Captured with the Phoenix ICON (100° field of view) · wide-field fundus photograph from neonatal ROP screening
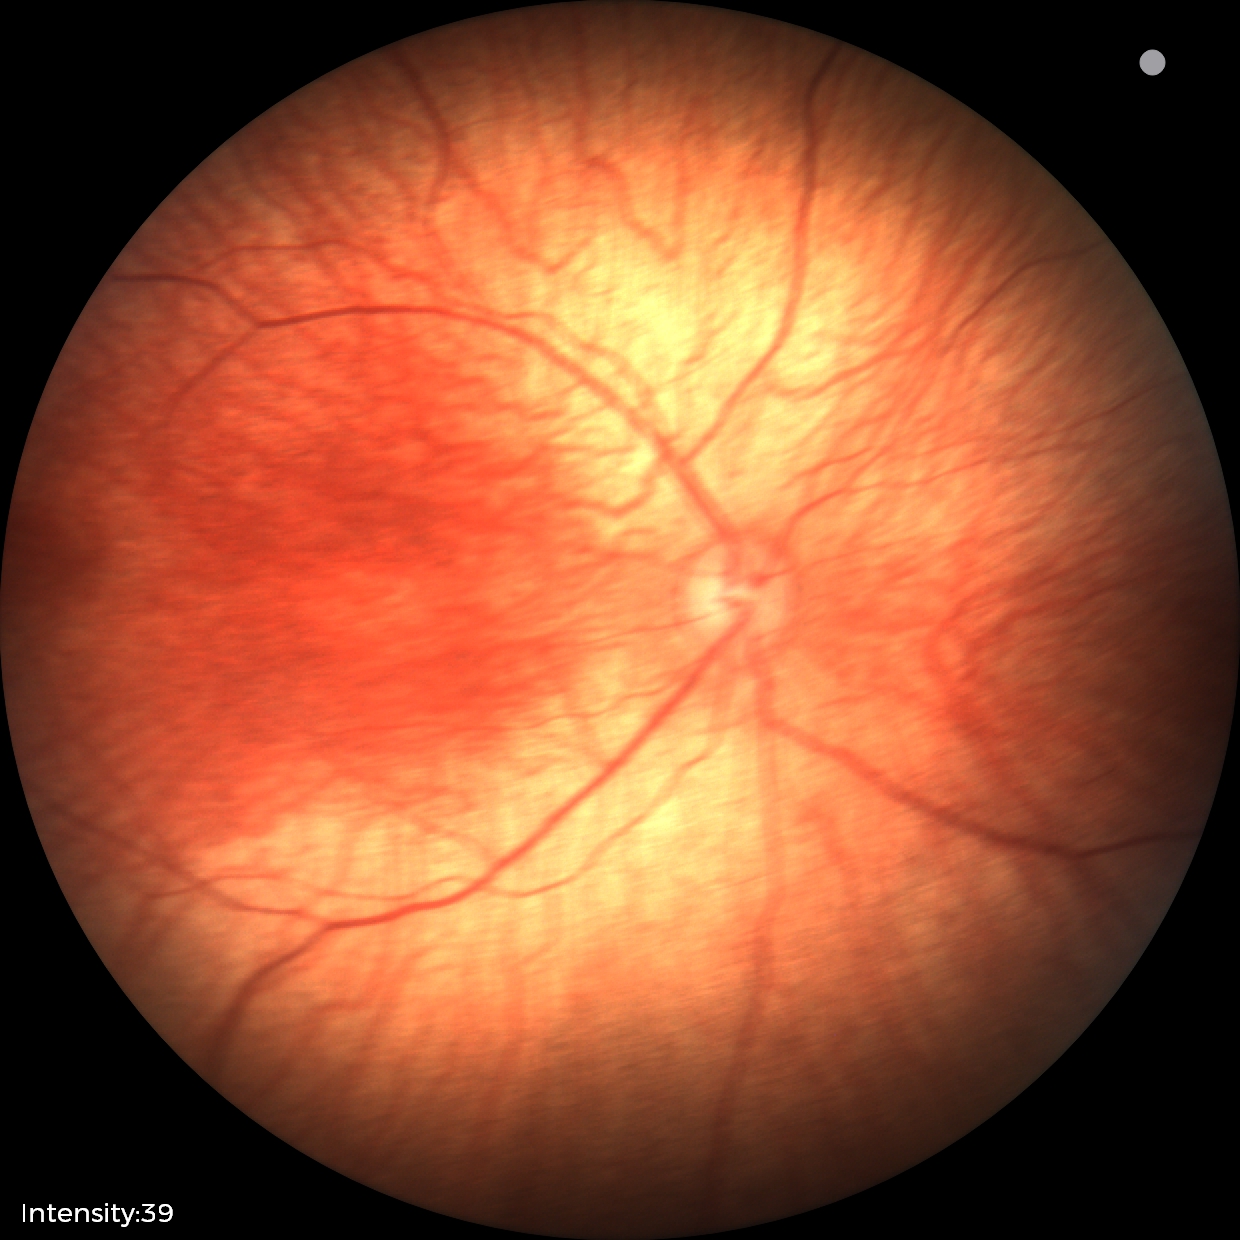
Screening examination with no abnormal retinal findings.